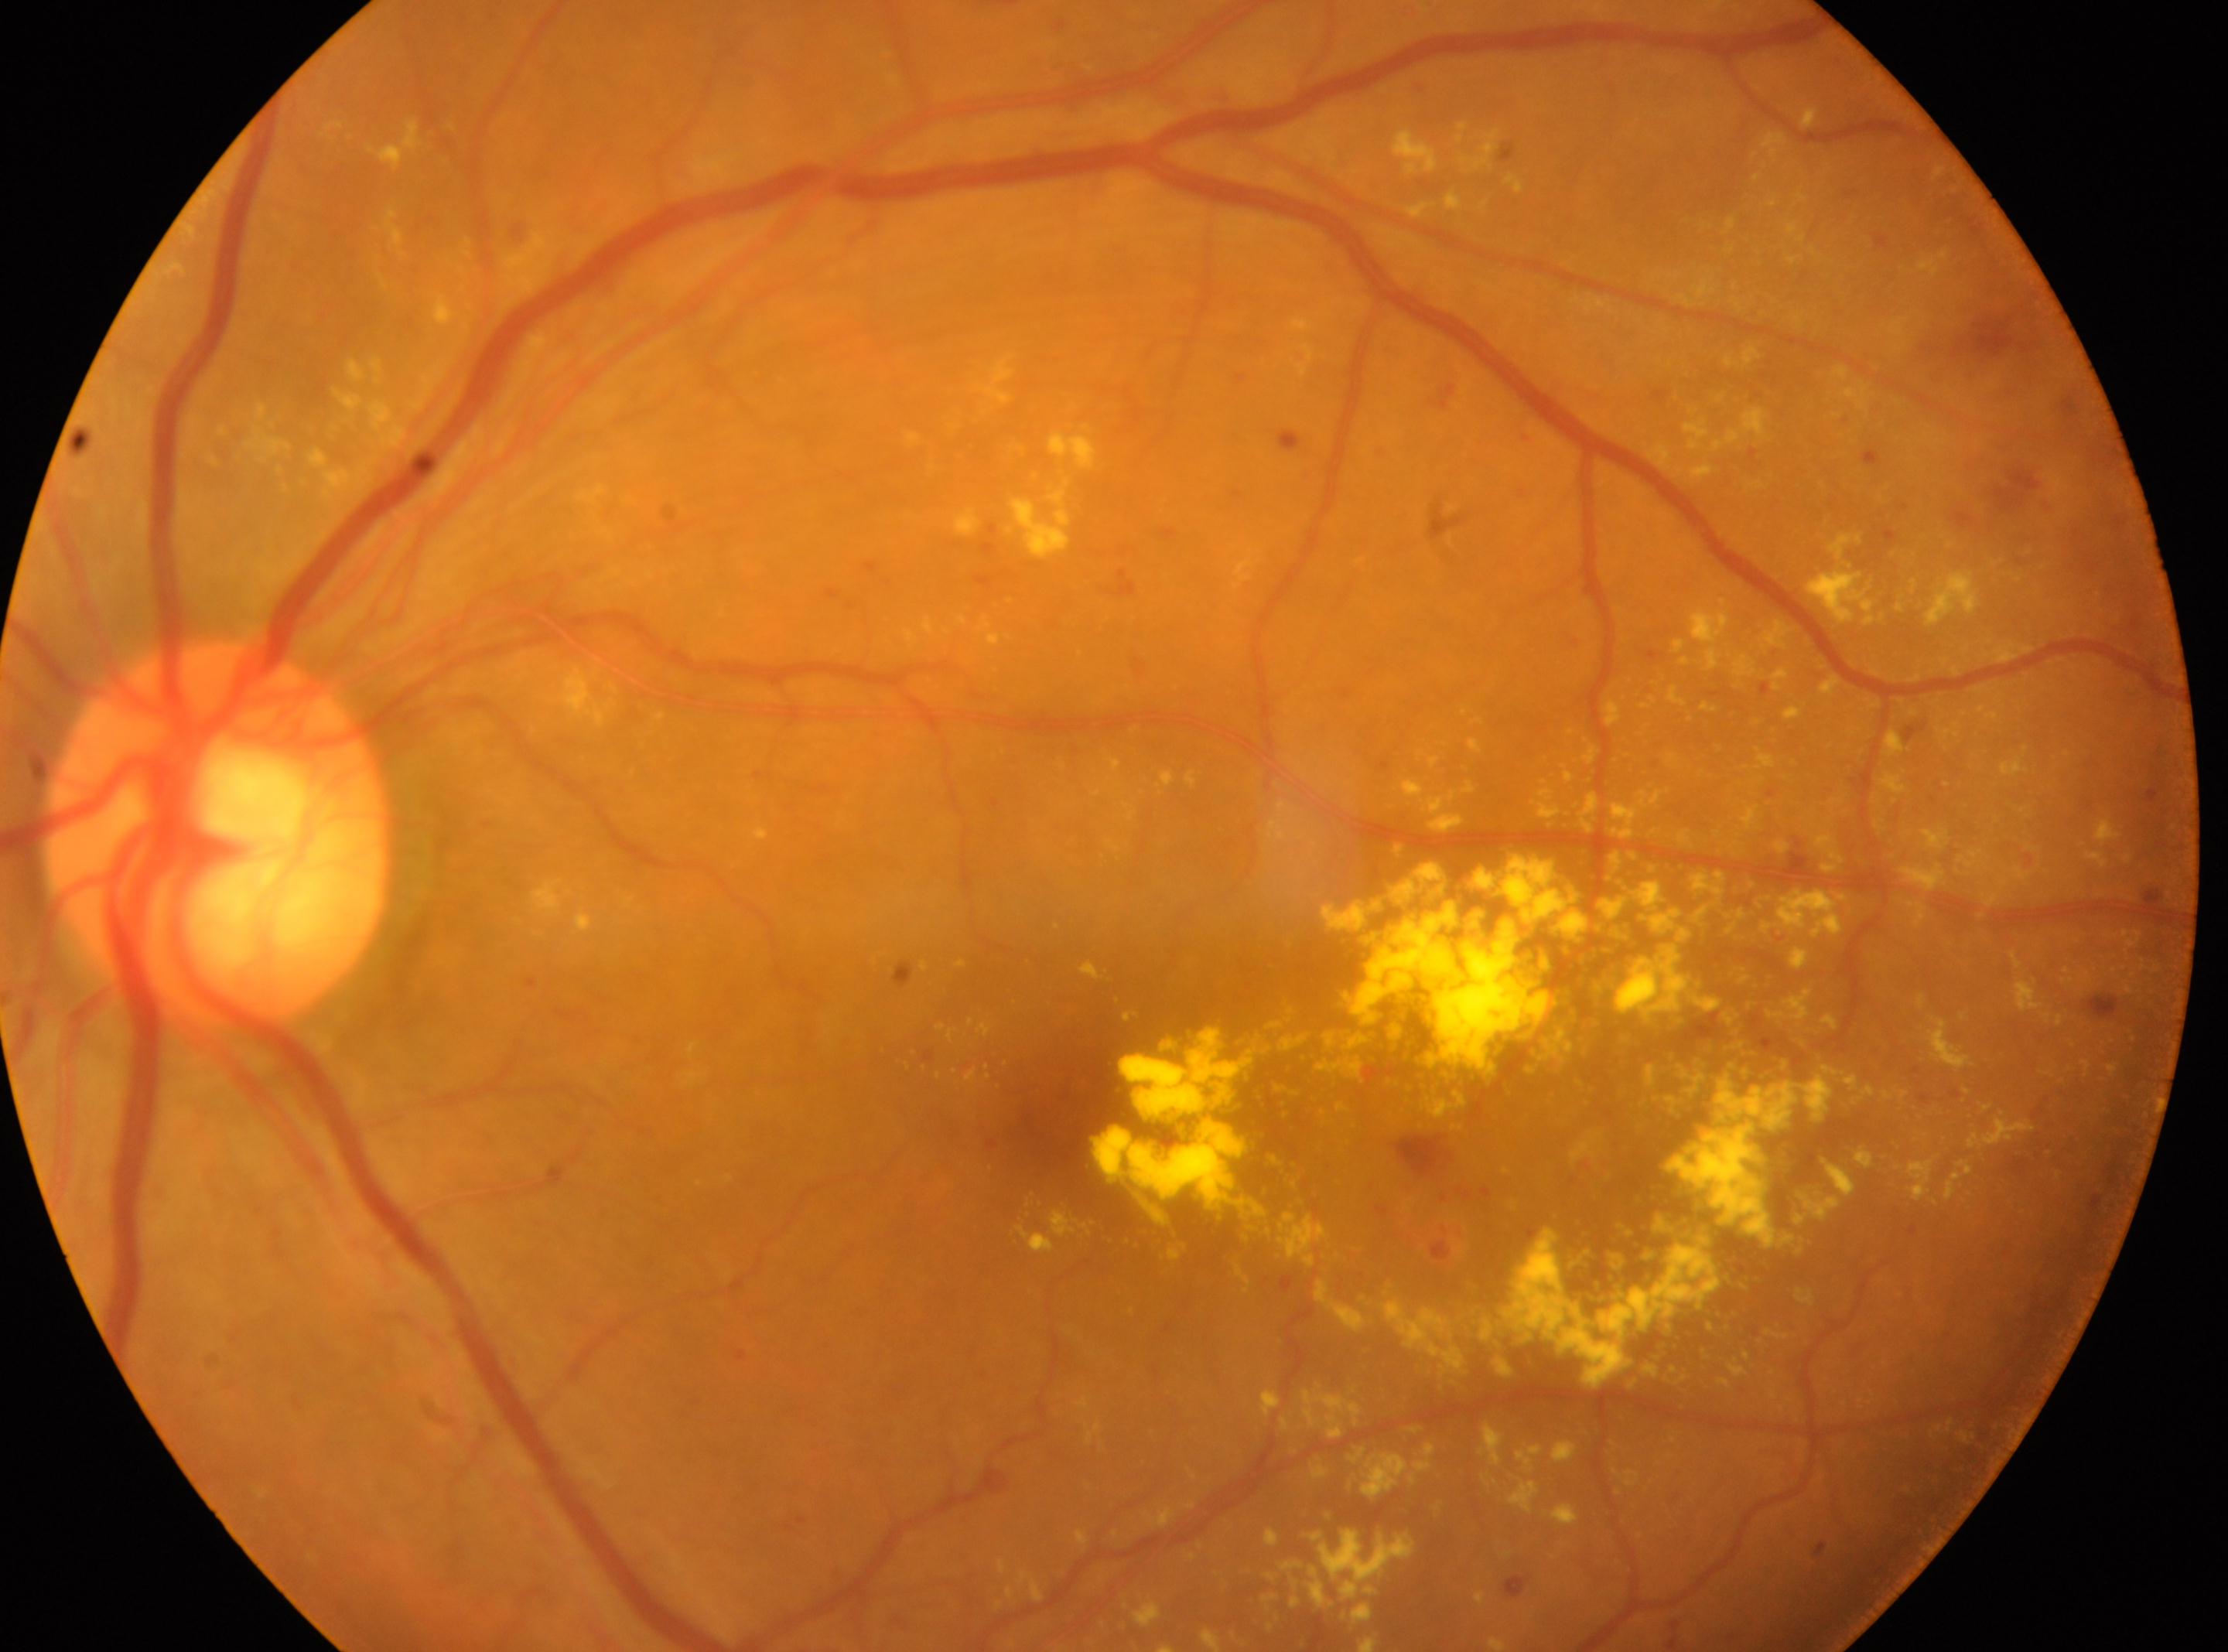
Imaged eye: left.
Fovea: x=1055, y=1108.
The optic disc is at x=217, y=838.
DR is grade 2.